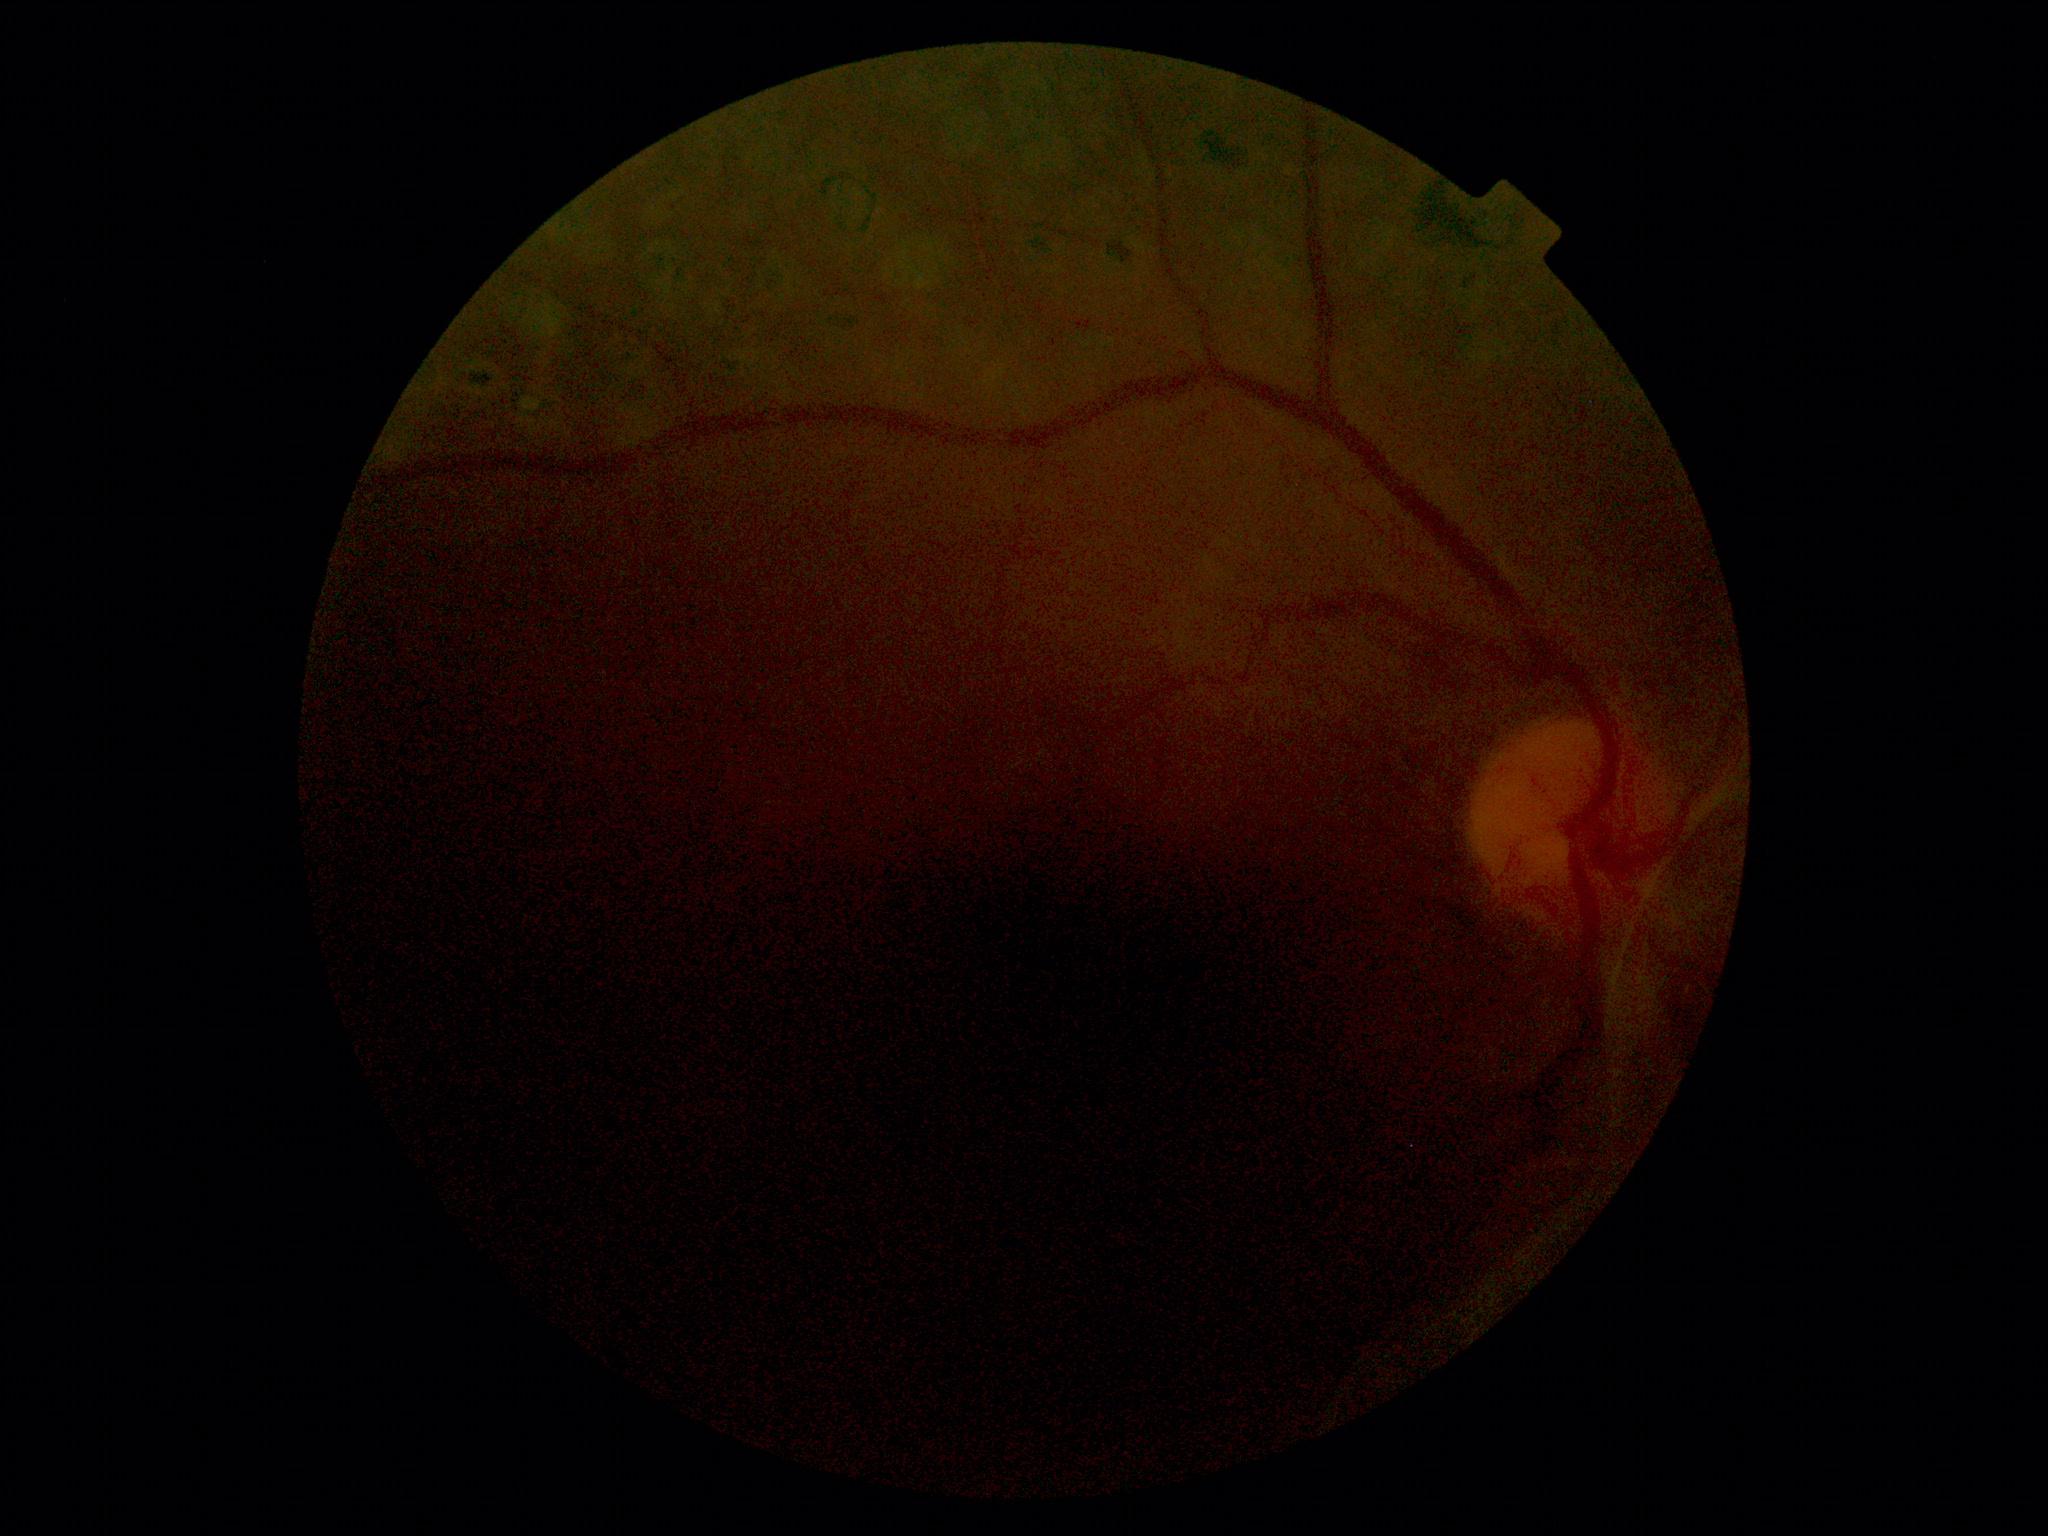 DR grade is 4/4.